Color fundus image · 45-degree field of view:
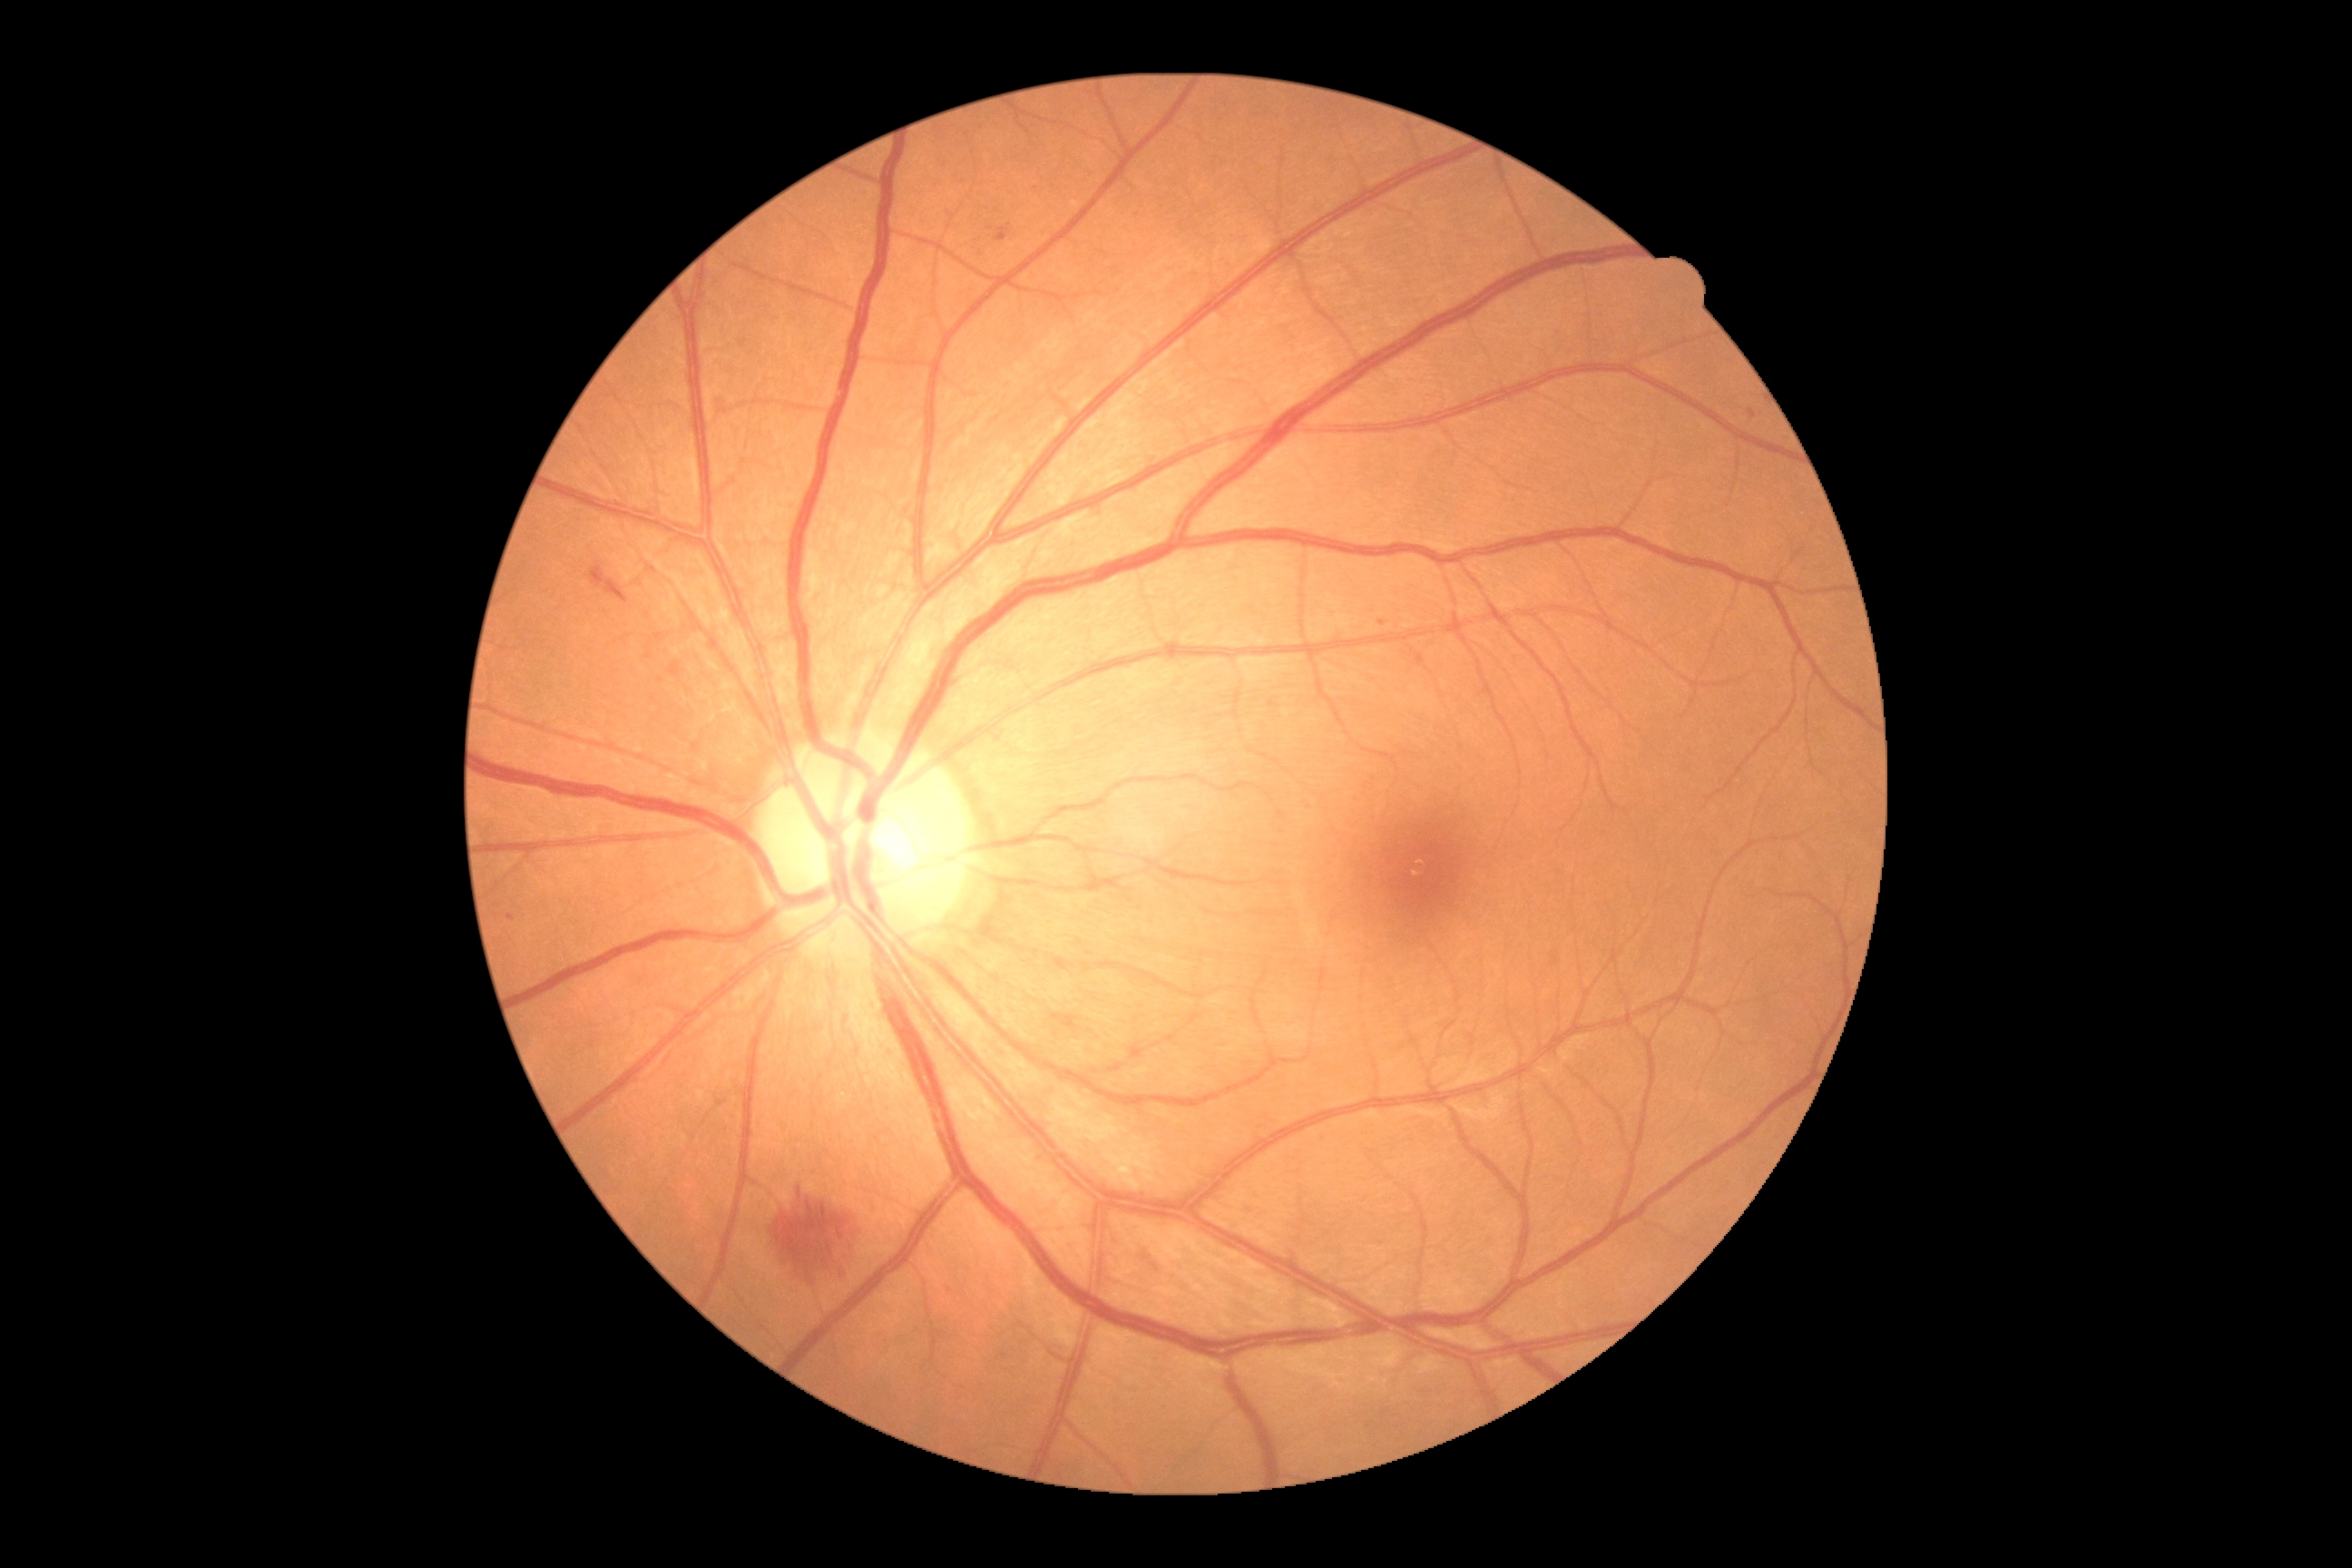

DR class: non-proliferative diabetic retinopathy | retinopathy grade: 2 (moderate NPDR).